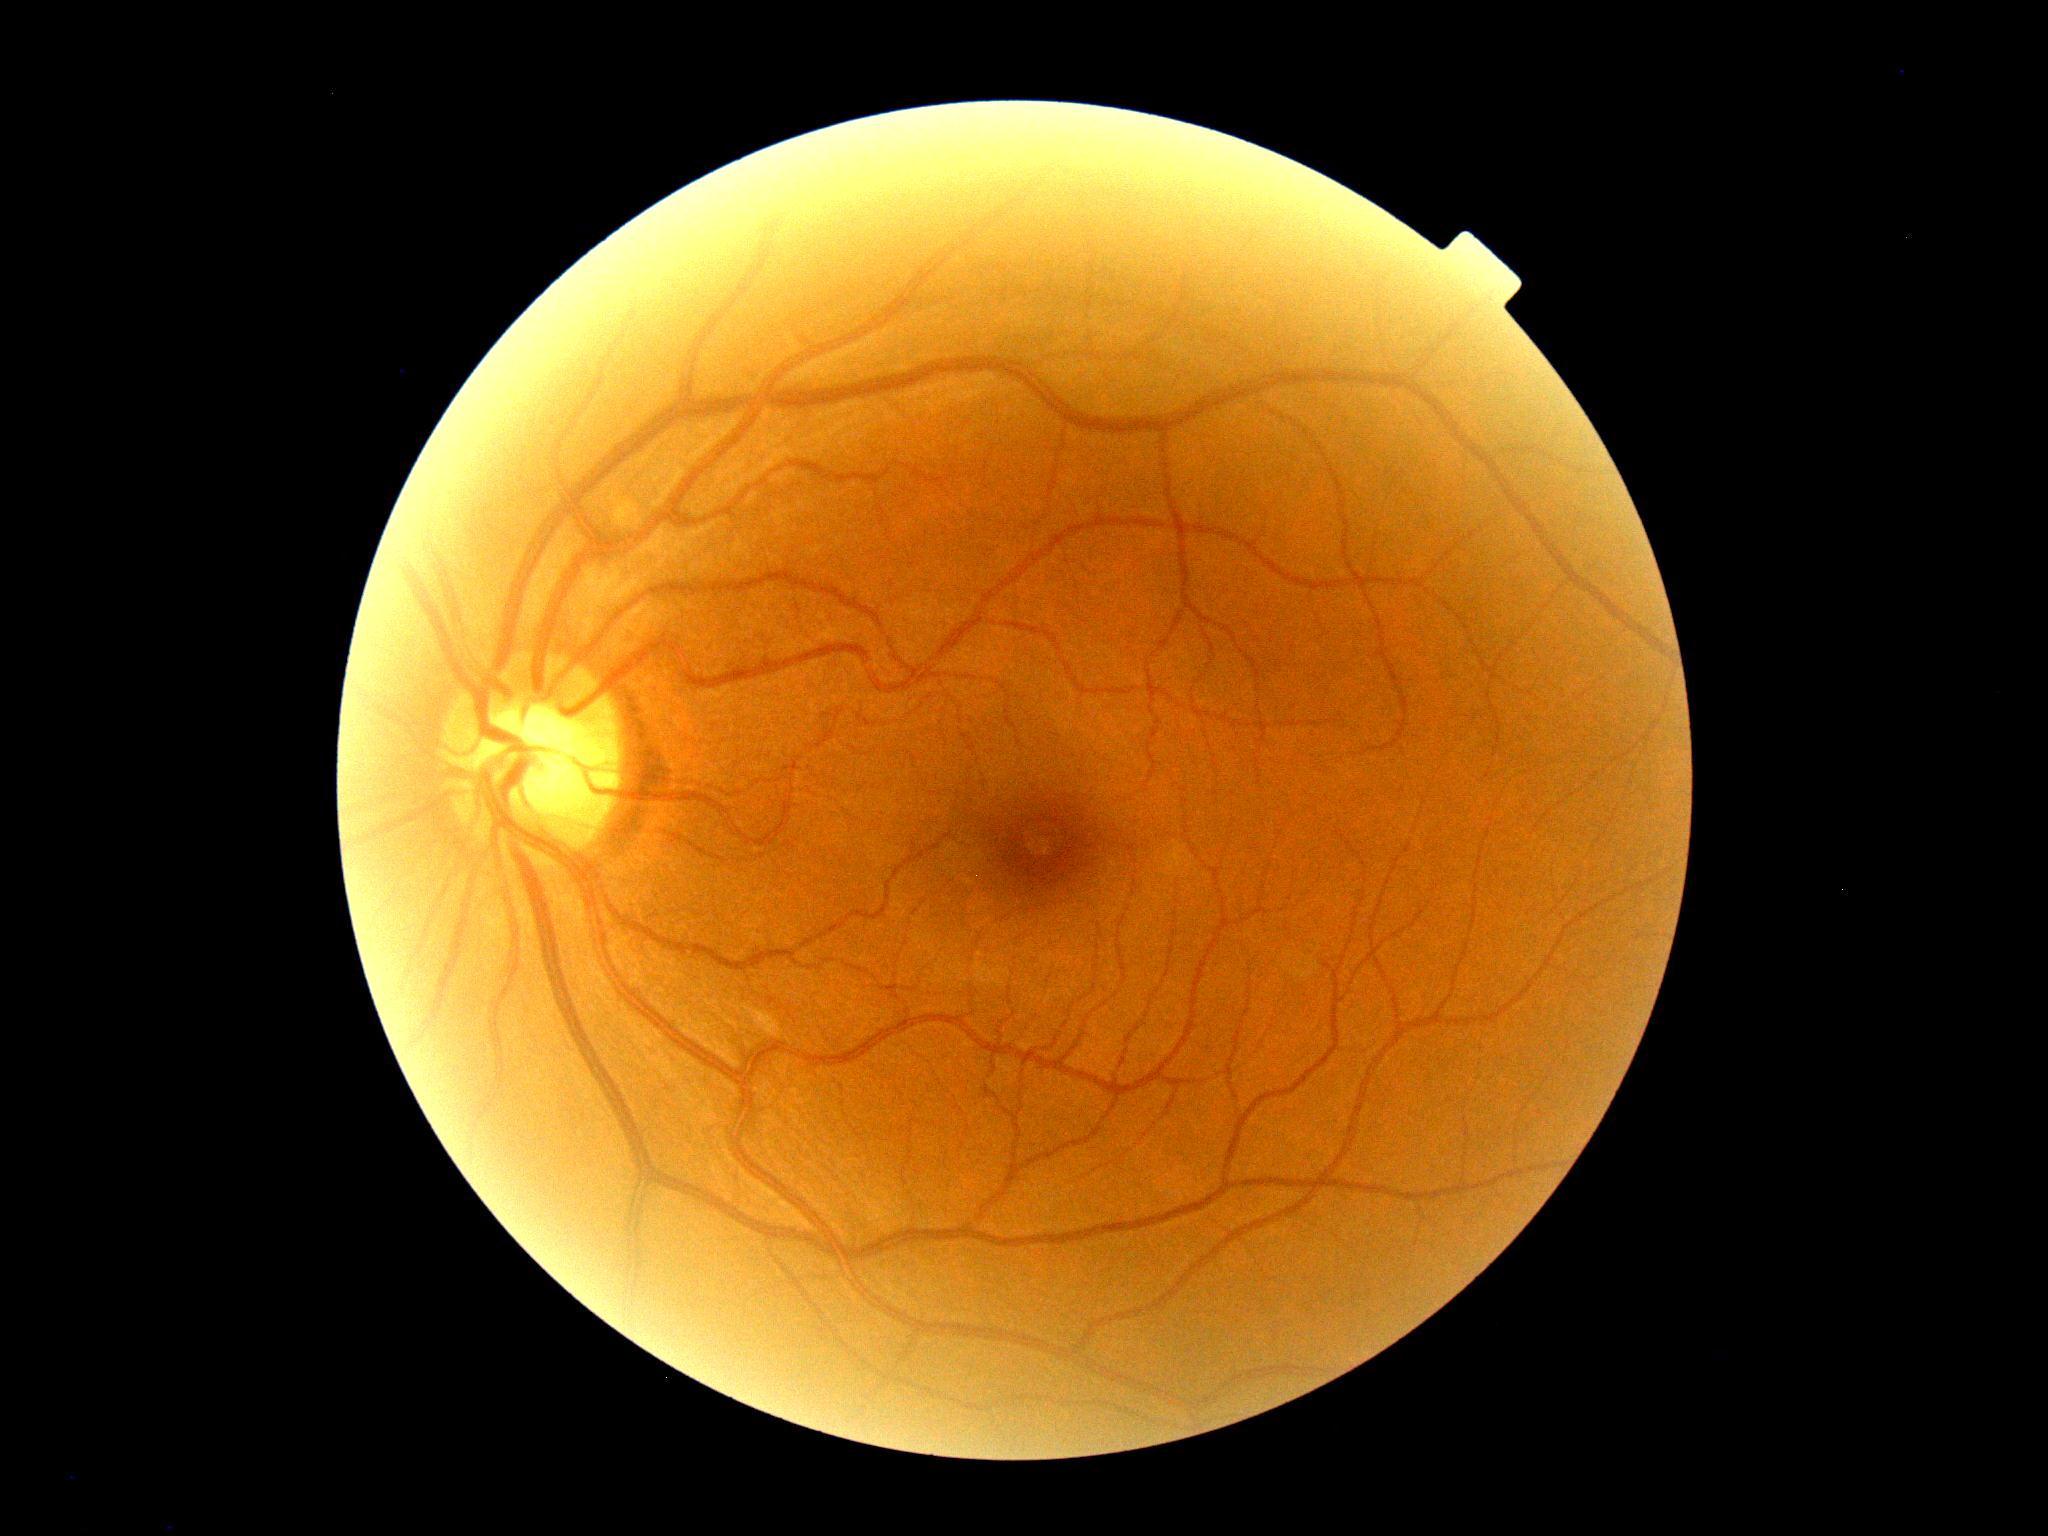
DR stage is 0/4 — no visible signs of diabetic retinopathy.